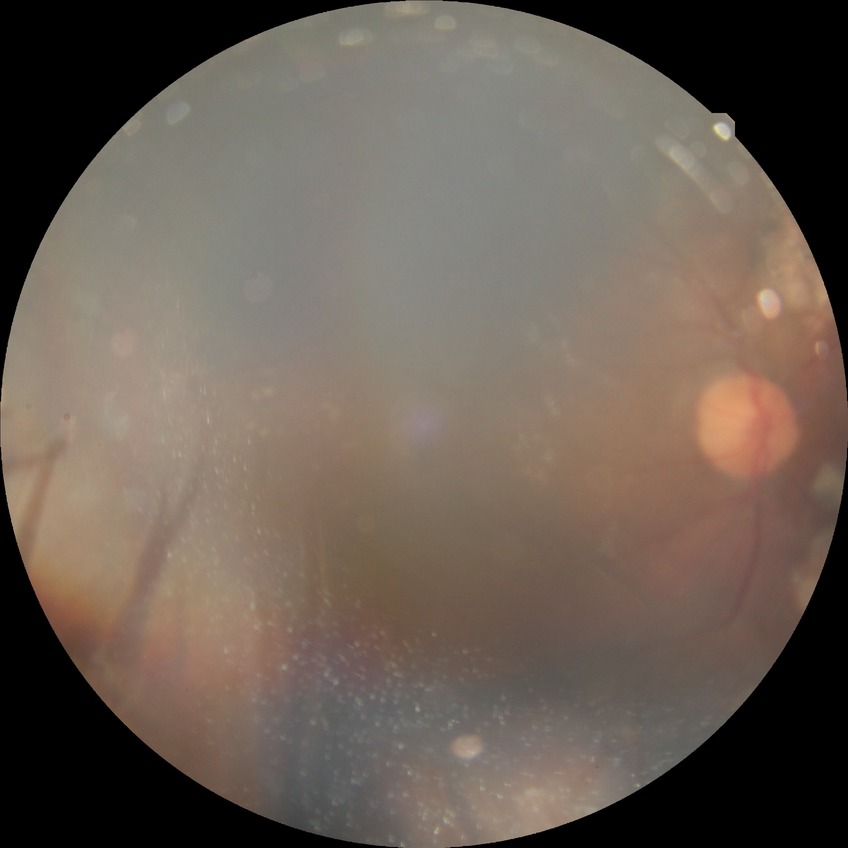
Diabetic retinopathy (DR): PDR (proliferative diabetic retinopathy).